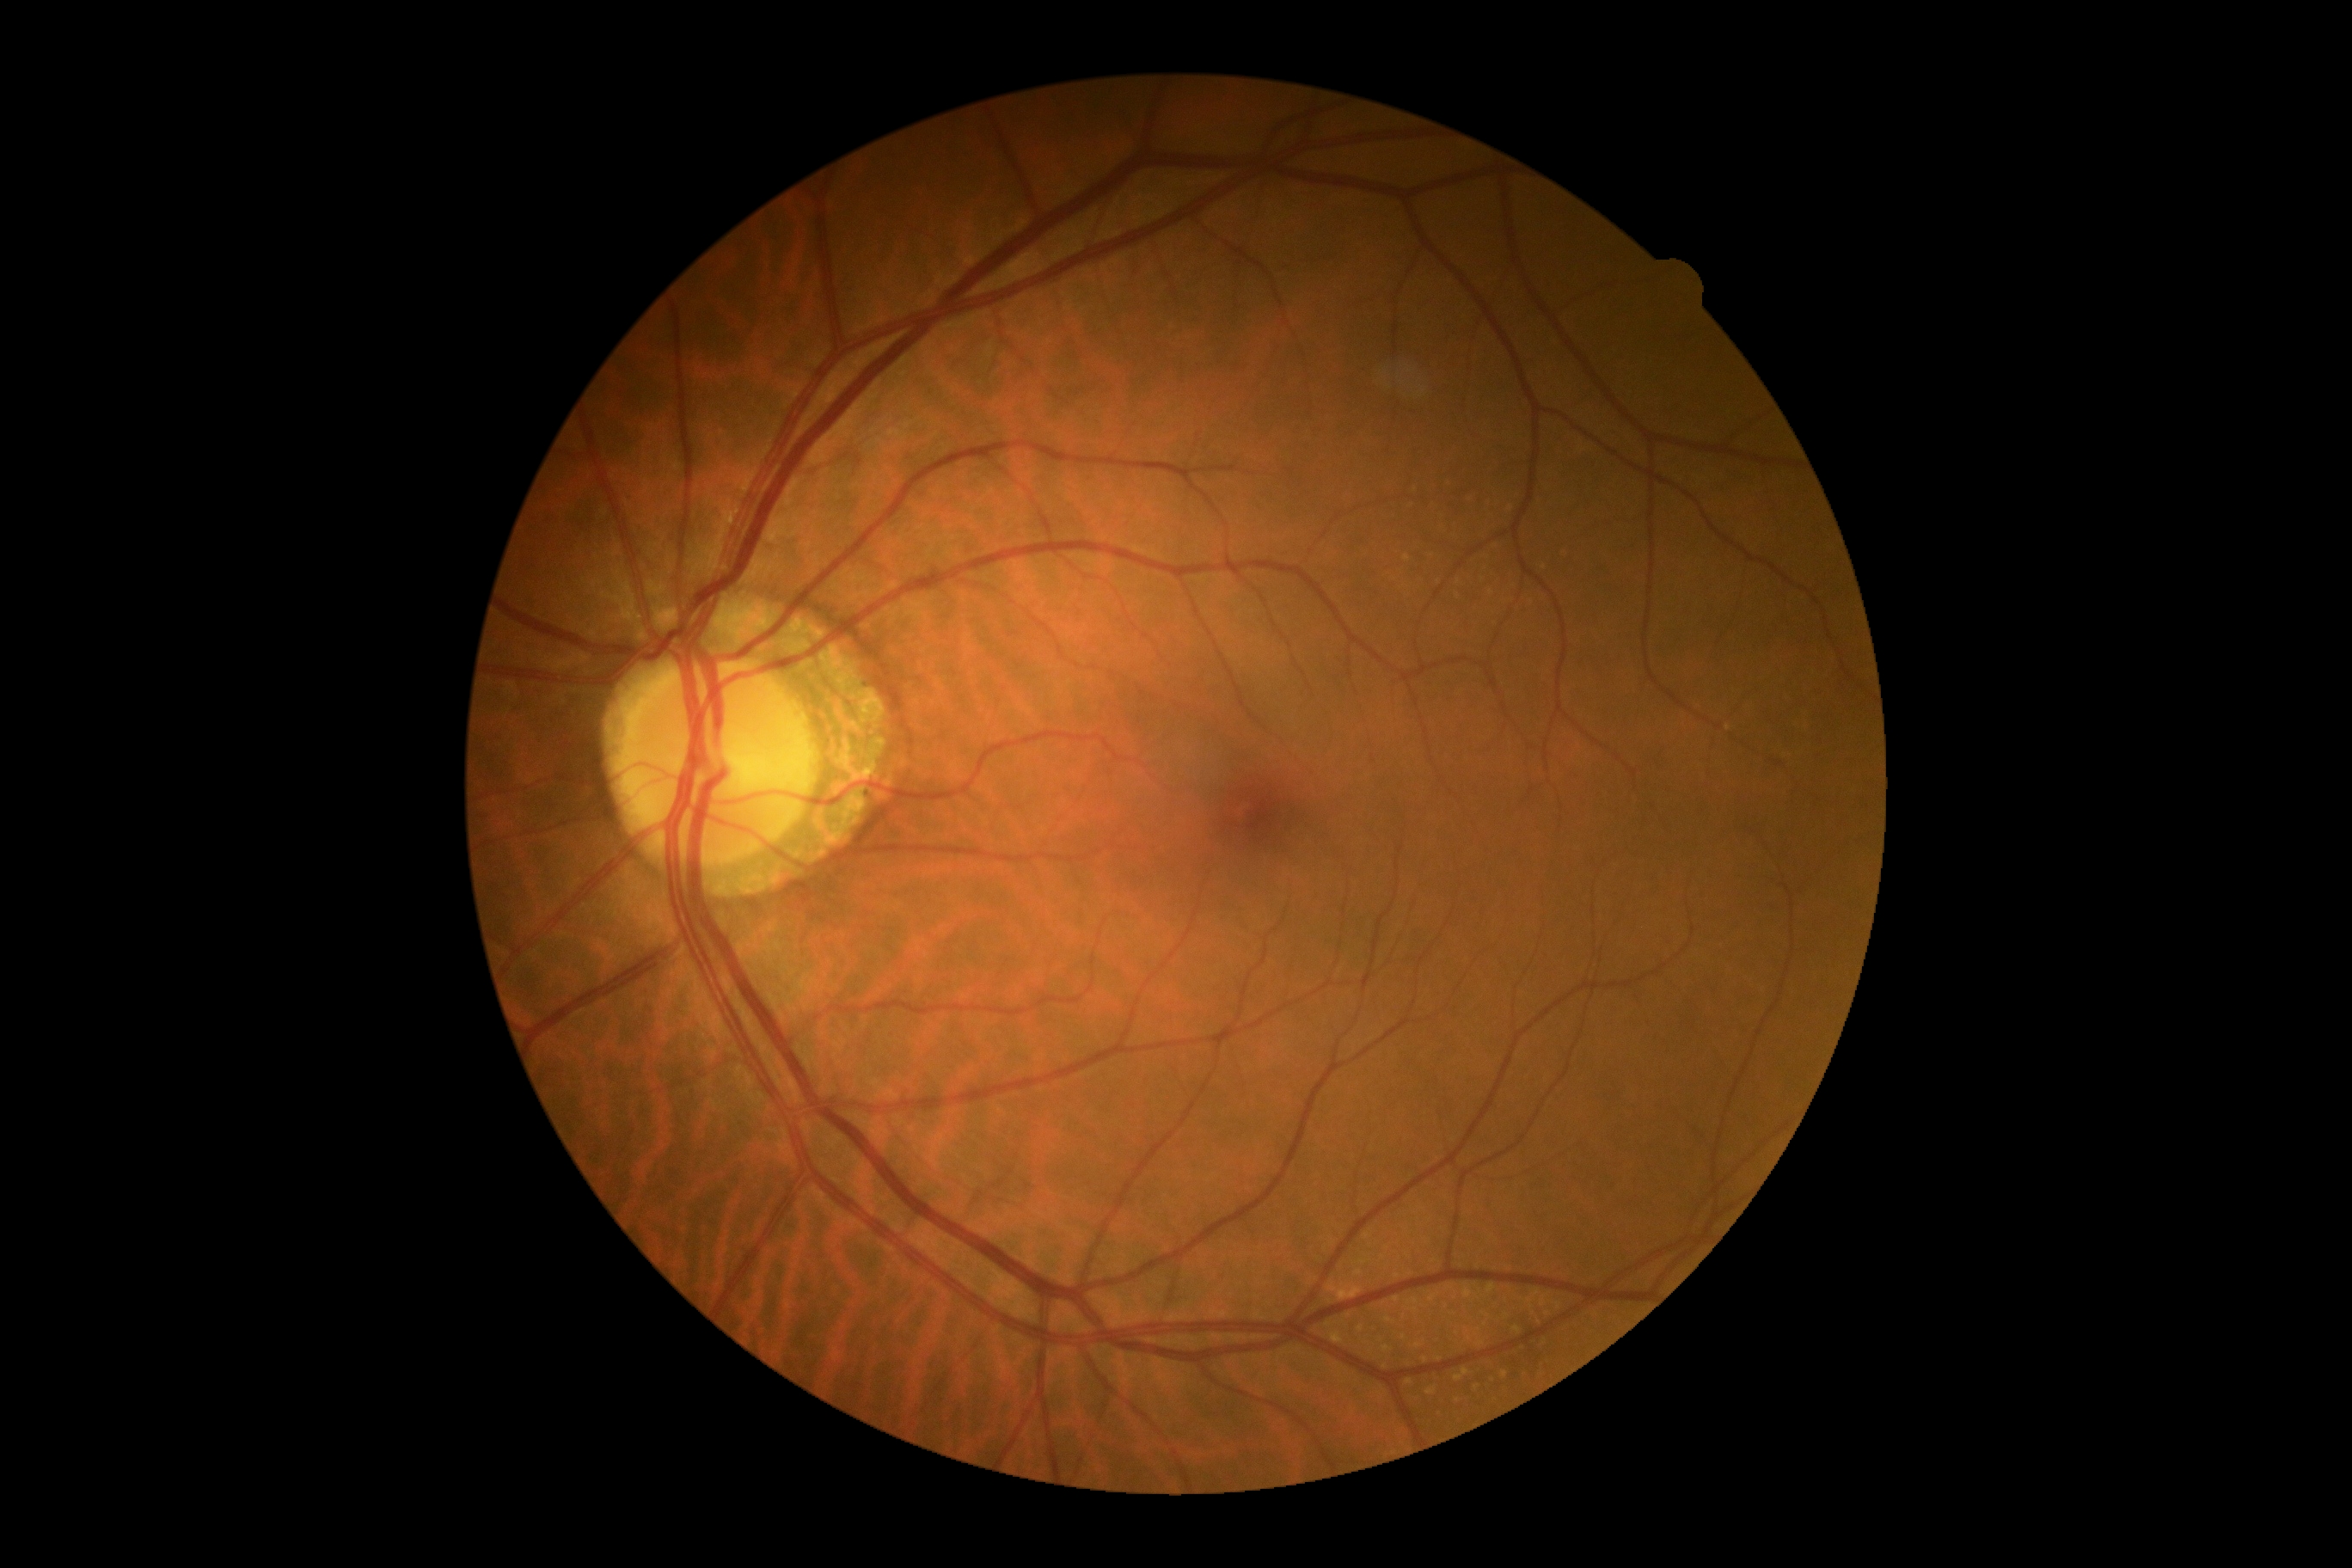
No apparent diabetic retinopathy.
DR is grade 0 — no visible signs of diabetic retinopathy.